Pediatric wide-field fundus photograph. Captured with the Clarity RetCam 3 (130° field of view). 640x480
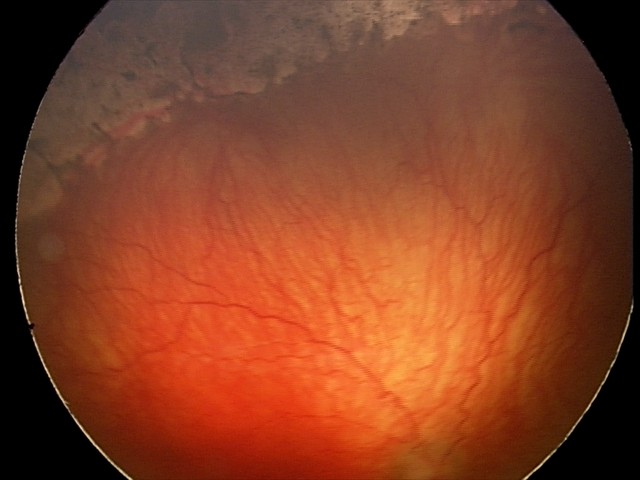

Assessment: aggressive retinopathy of prematurity (A-ROP); plus disease.